45° field of view:
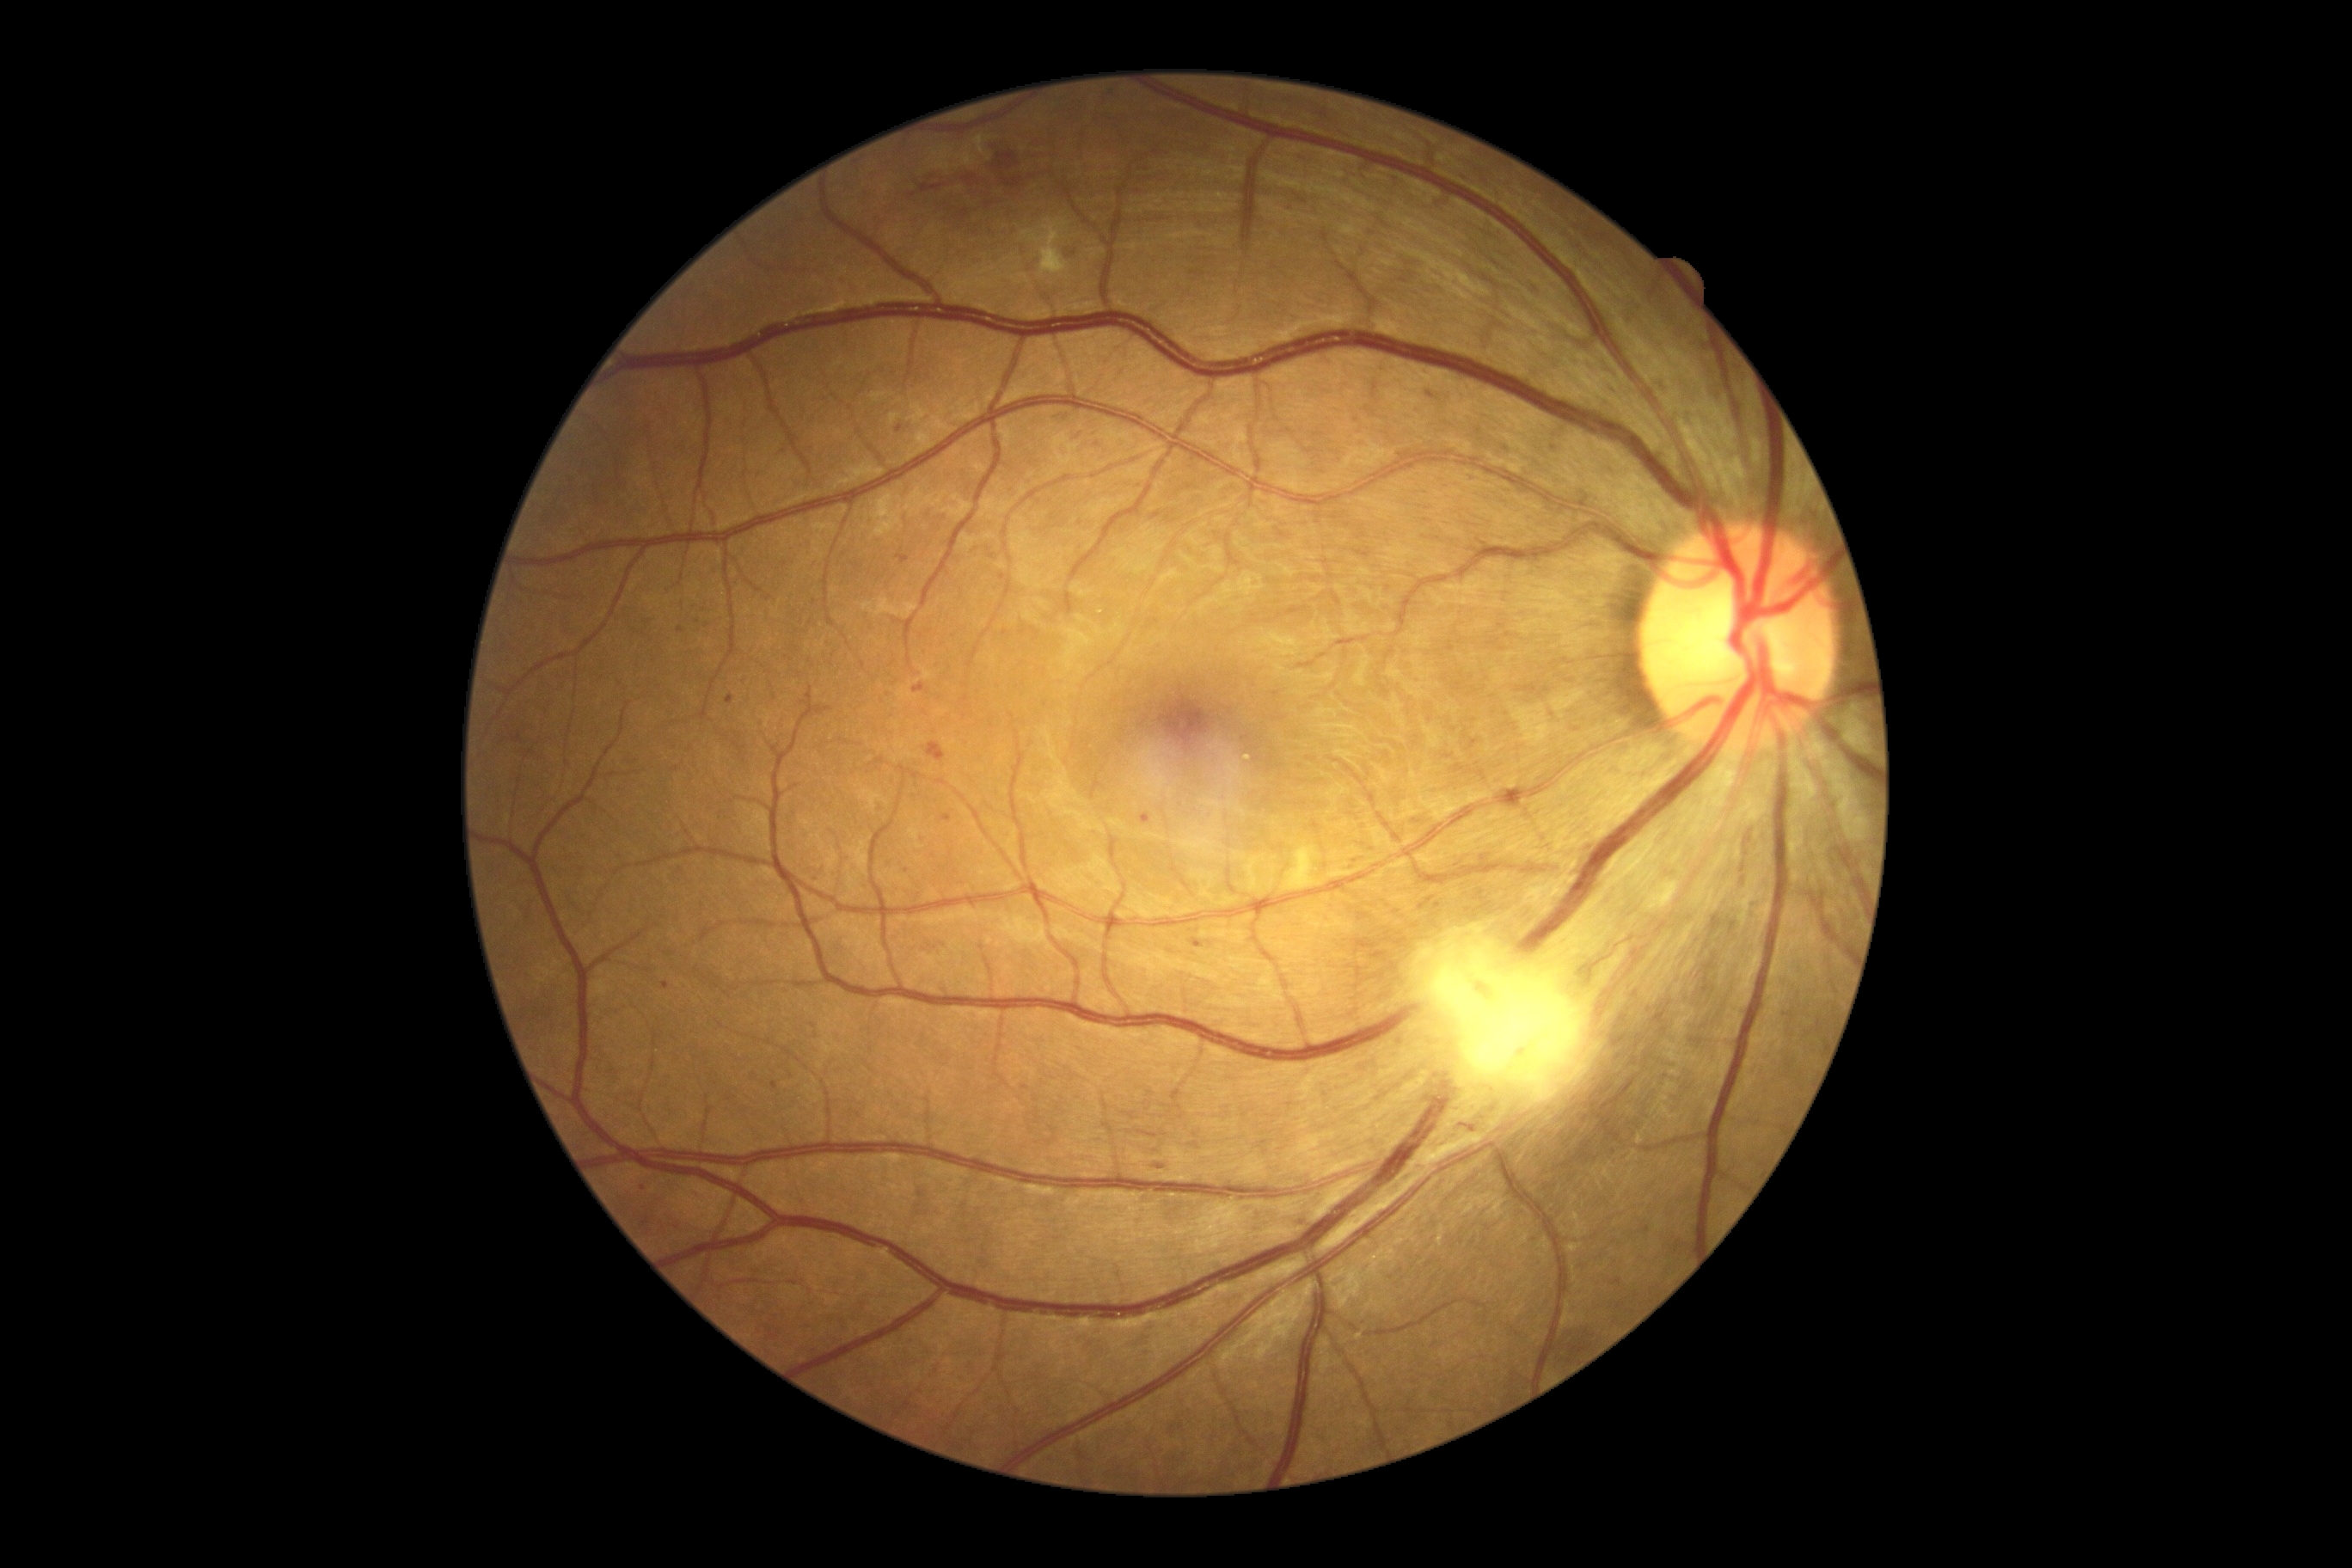
* diabetic retinopathy: grade 2 (moderate NPDR)